Pediatric wide-field fundus photograph · Phoenix ICON, 100° FOV · image size 1240x1240 — 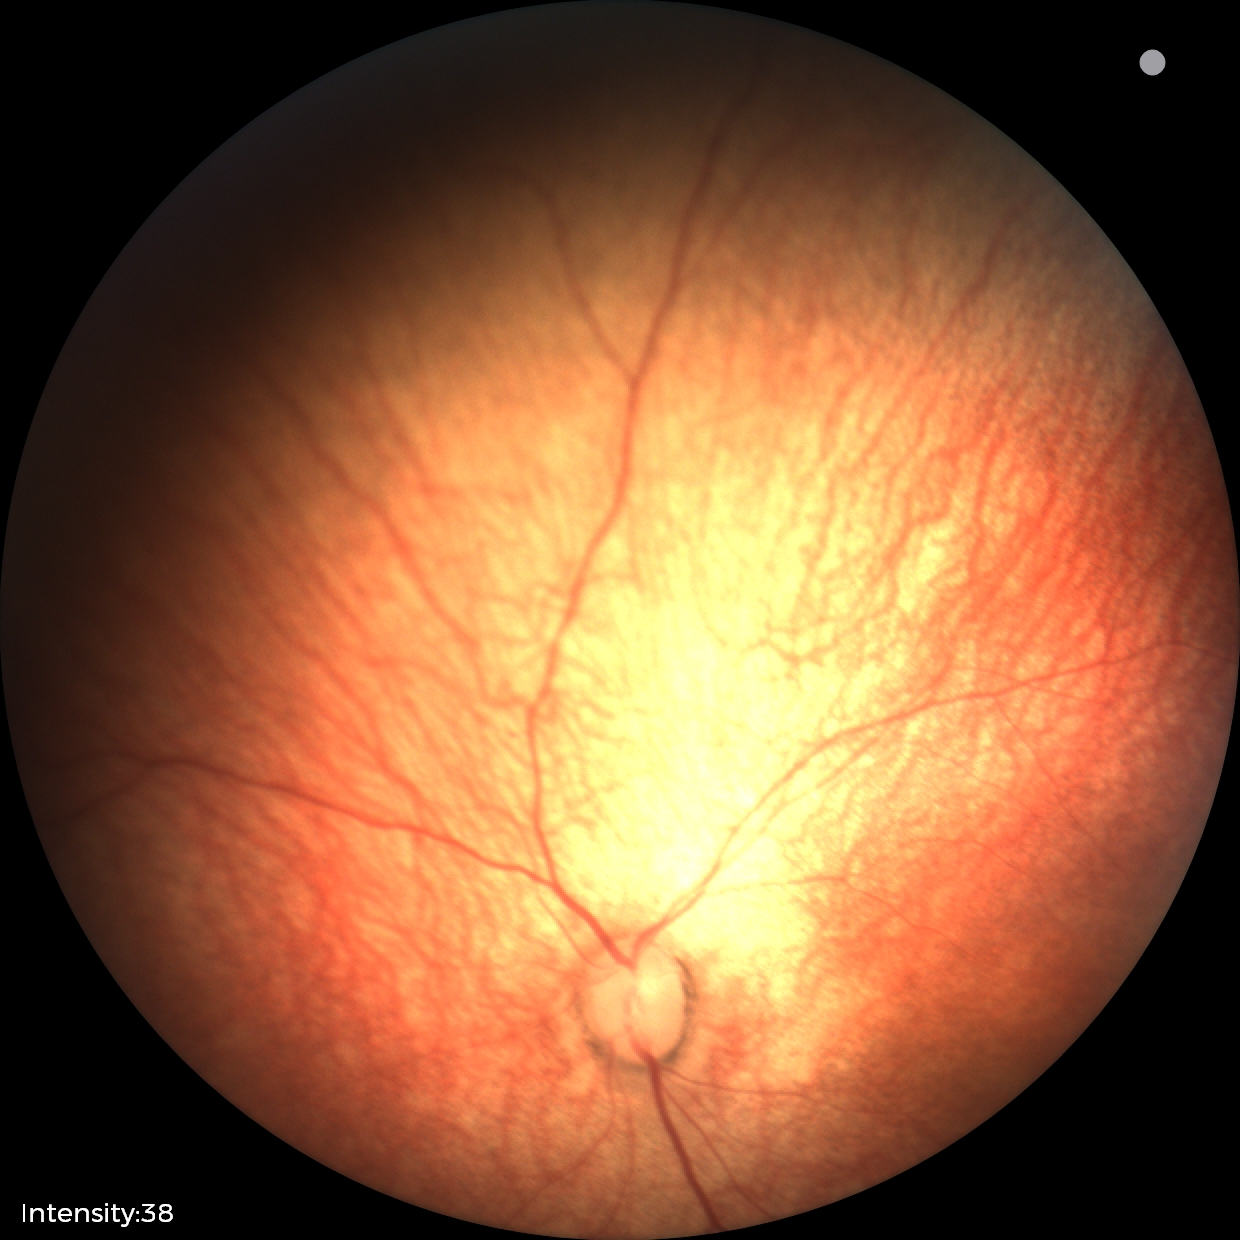 Assessment: normal retinal appearance.